FOV: 45 degrees. Color fundus photograph. Image size 2352x1568.
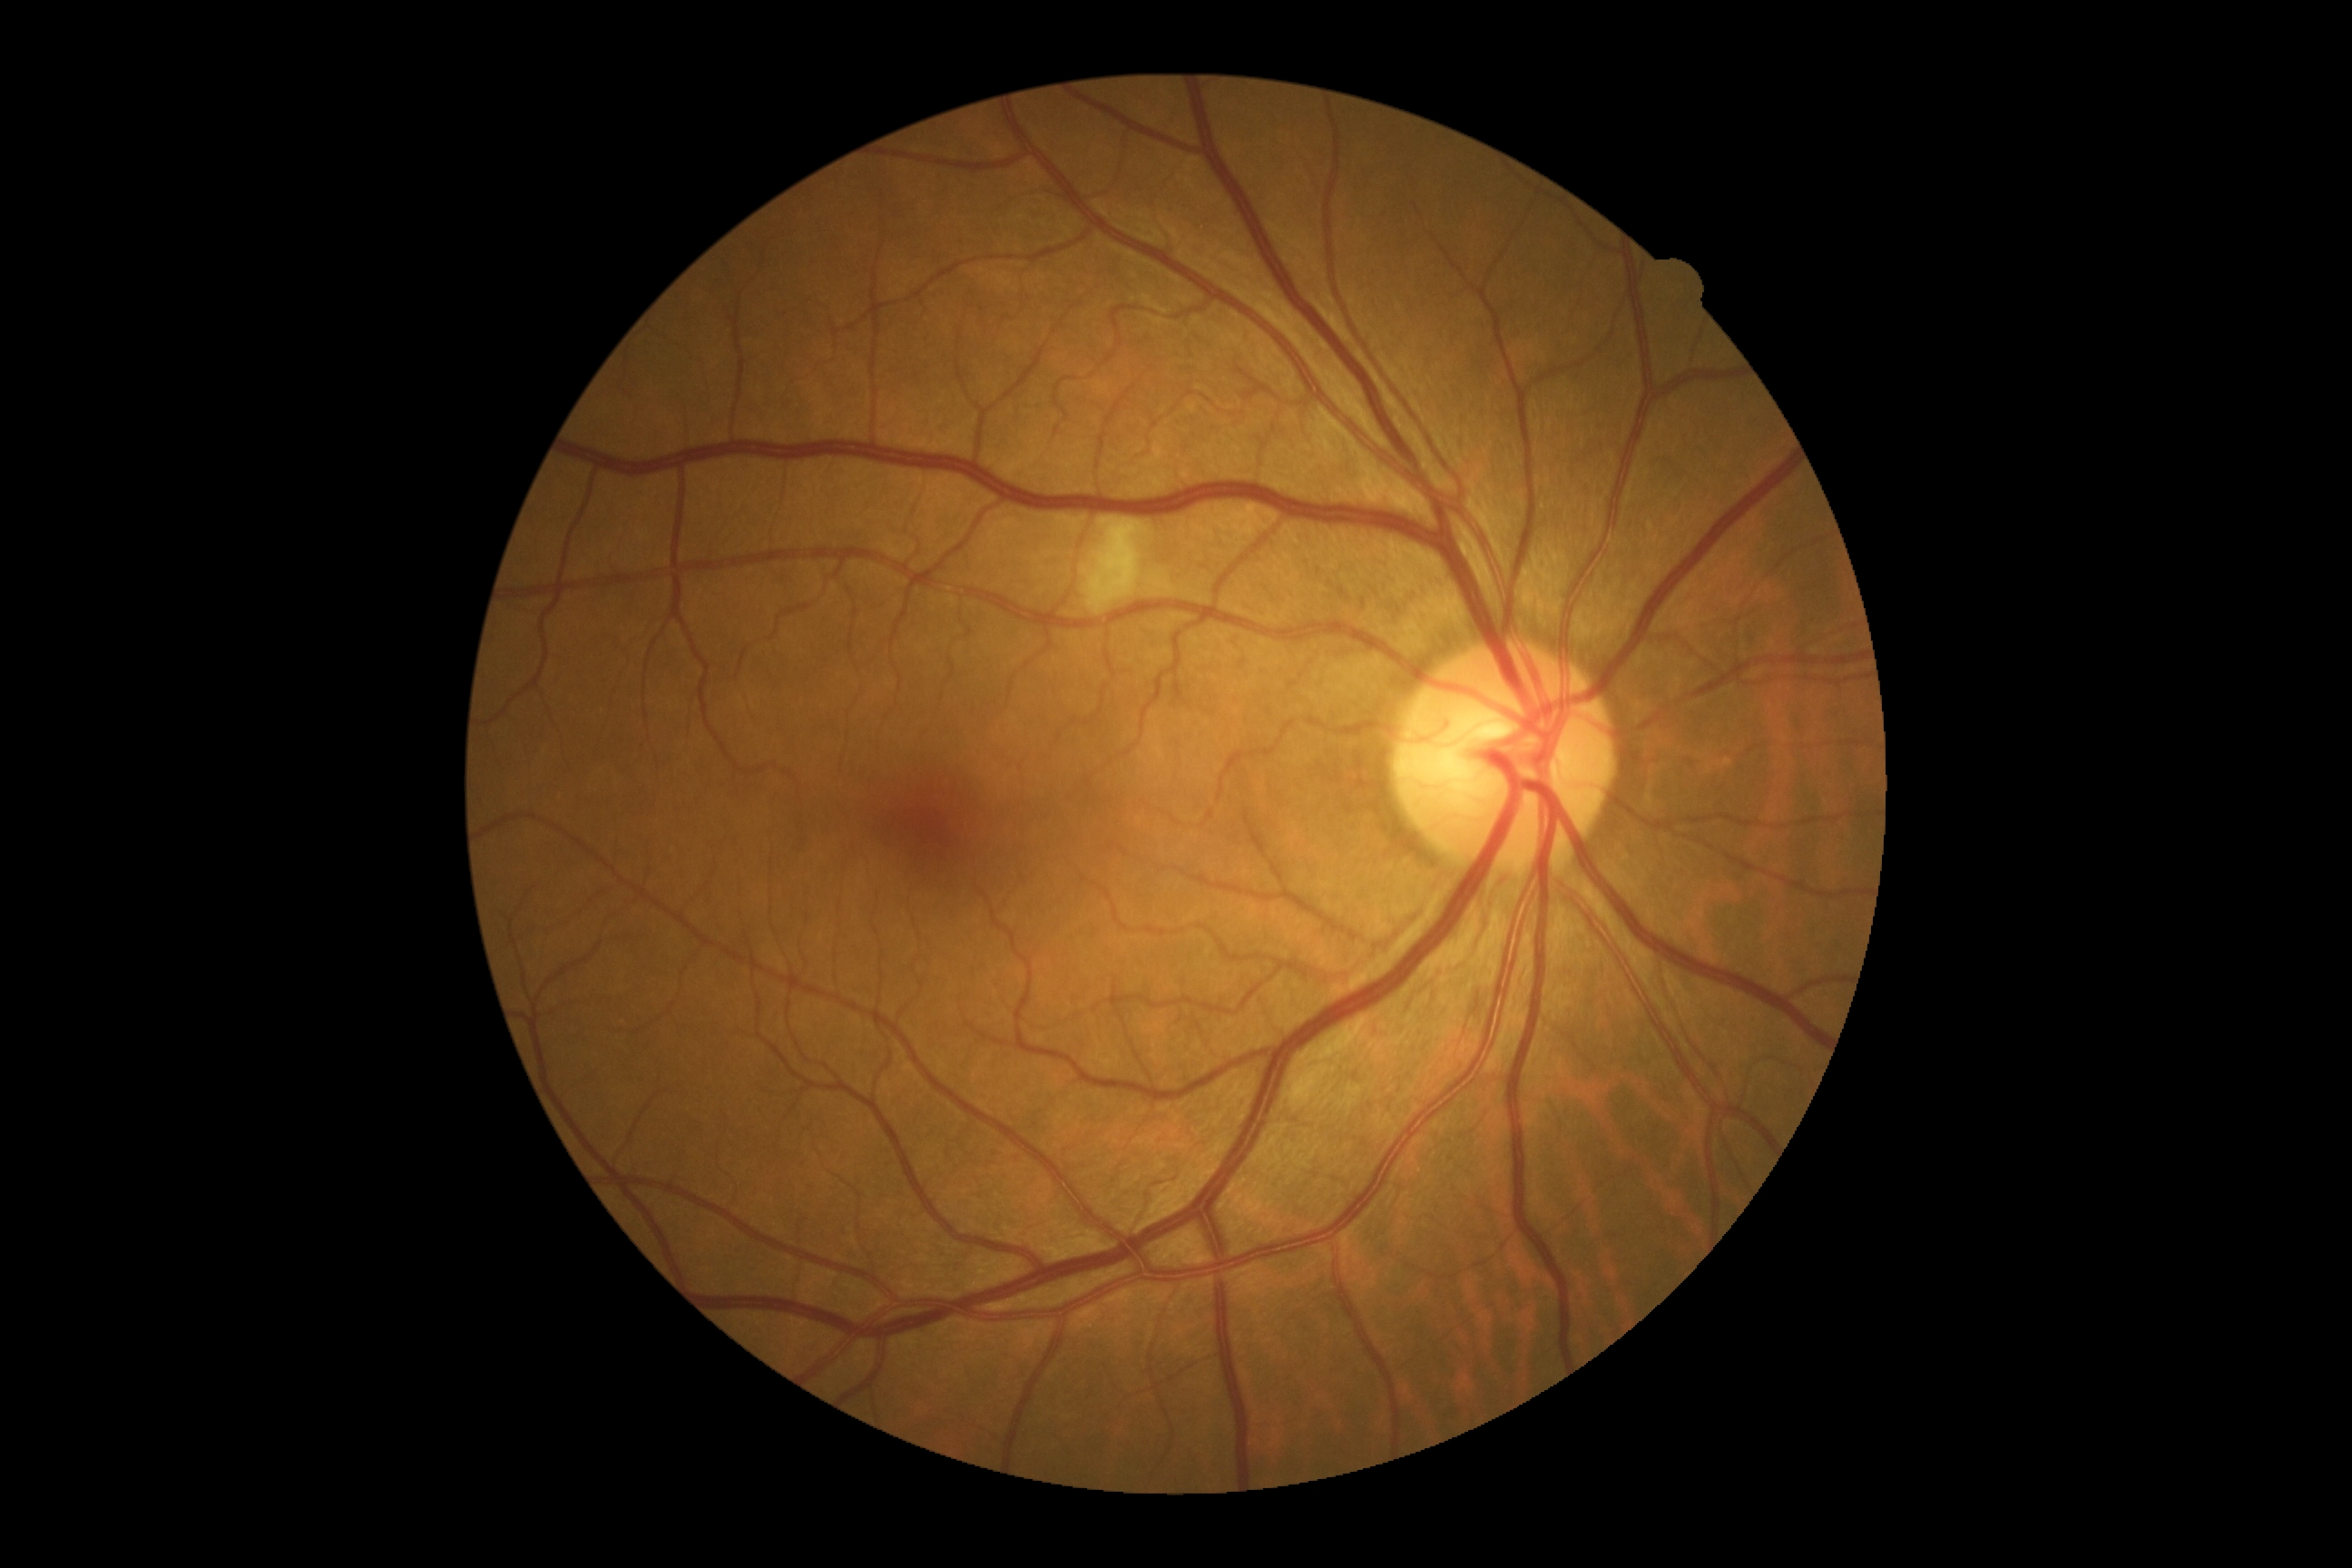 Diabetic retinopathy (DR) is 2 — more than just microaneurysms but less than severe NPDR.
The retinopathy is classified as non-proliferative diabetic retinopathy.